Nonmydriatic · FOV: 45 degrees.
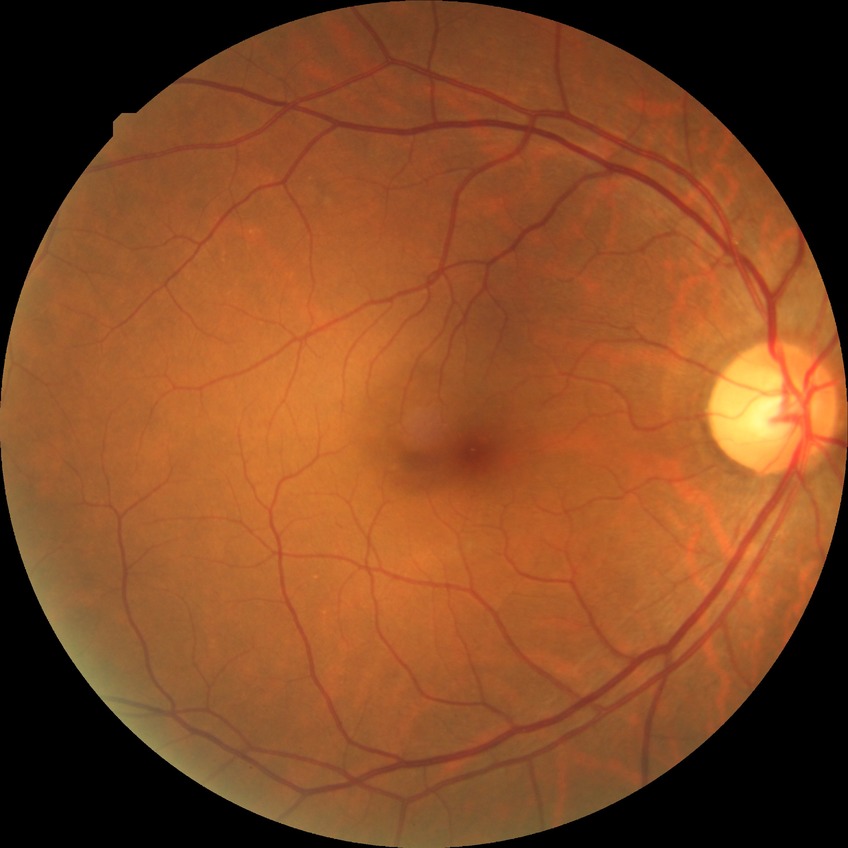

Diabetic retinopathy (DR) is NDR (no diabetic retinopathy).